Color fundus image.
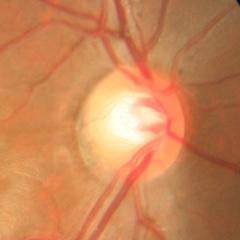

Q: Glaucoma assessment?
A: No — no glaucomatous optic neuropathy.